Wide-field fundus image from infant ROP screening
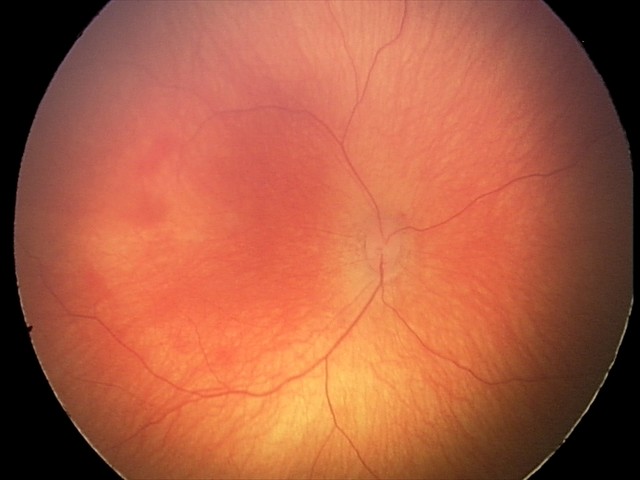
Screening series with retinal hemorrhages.